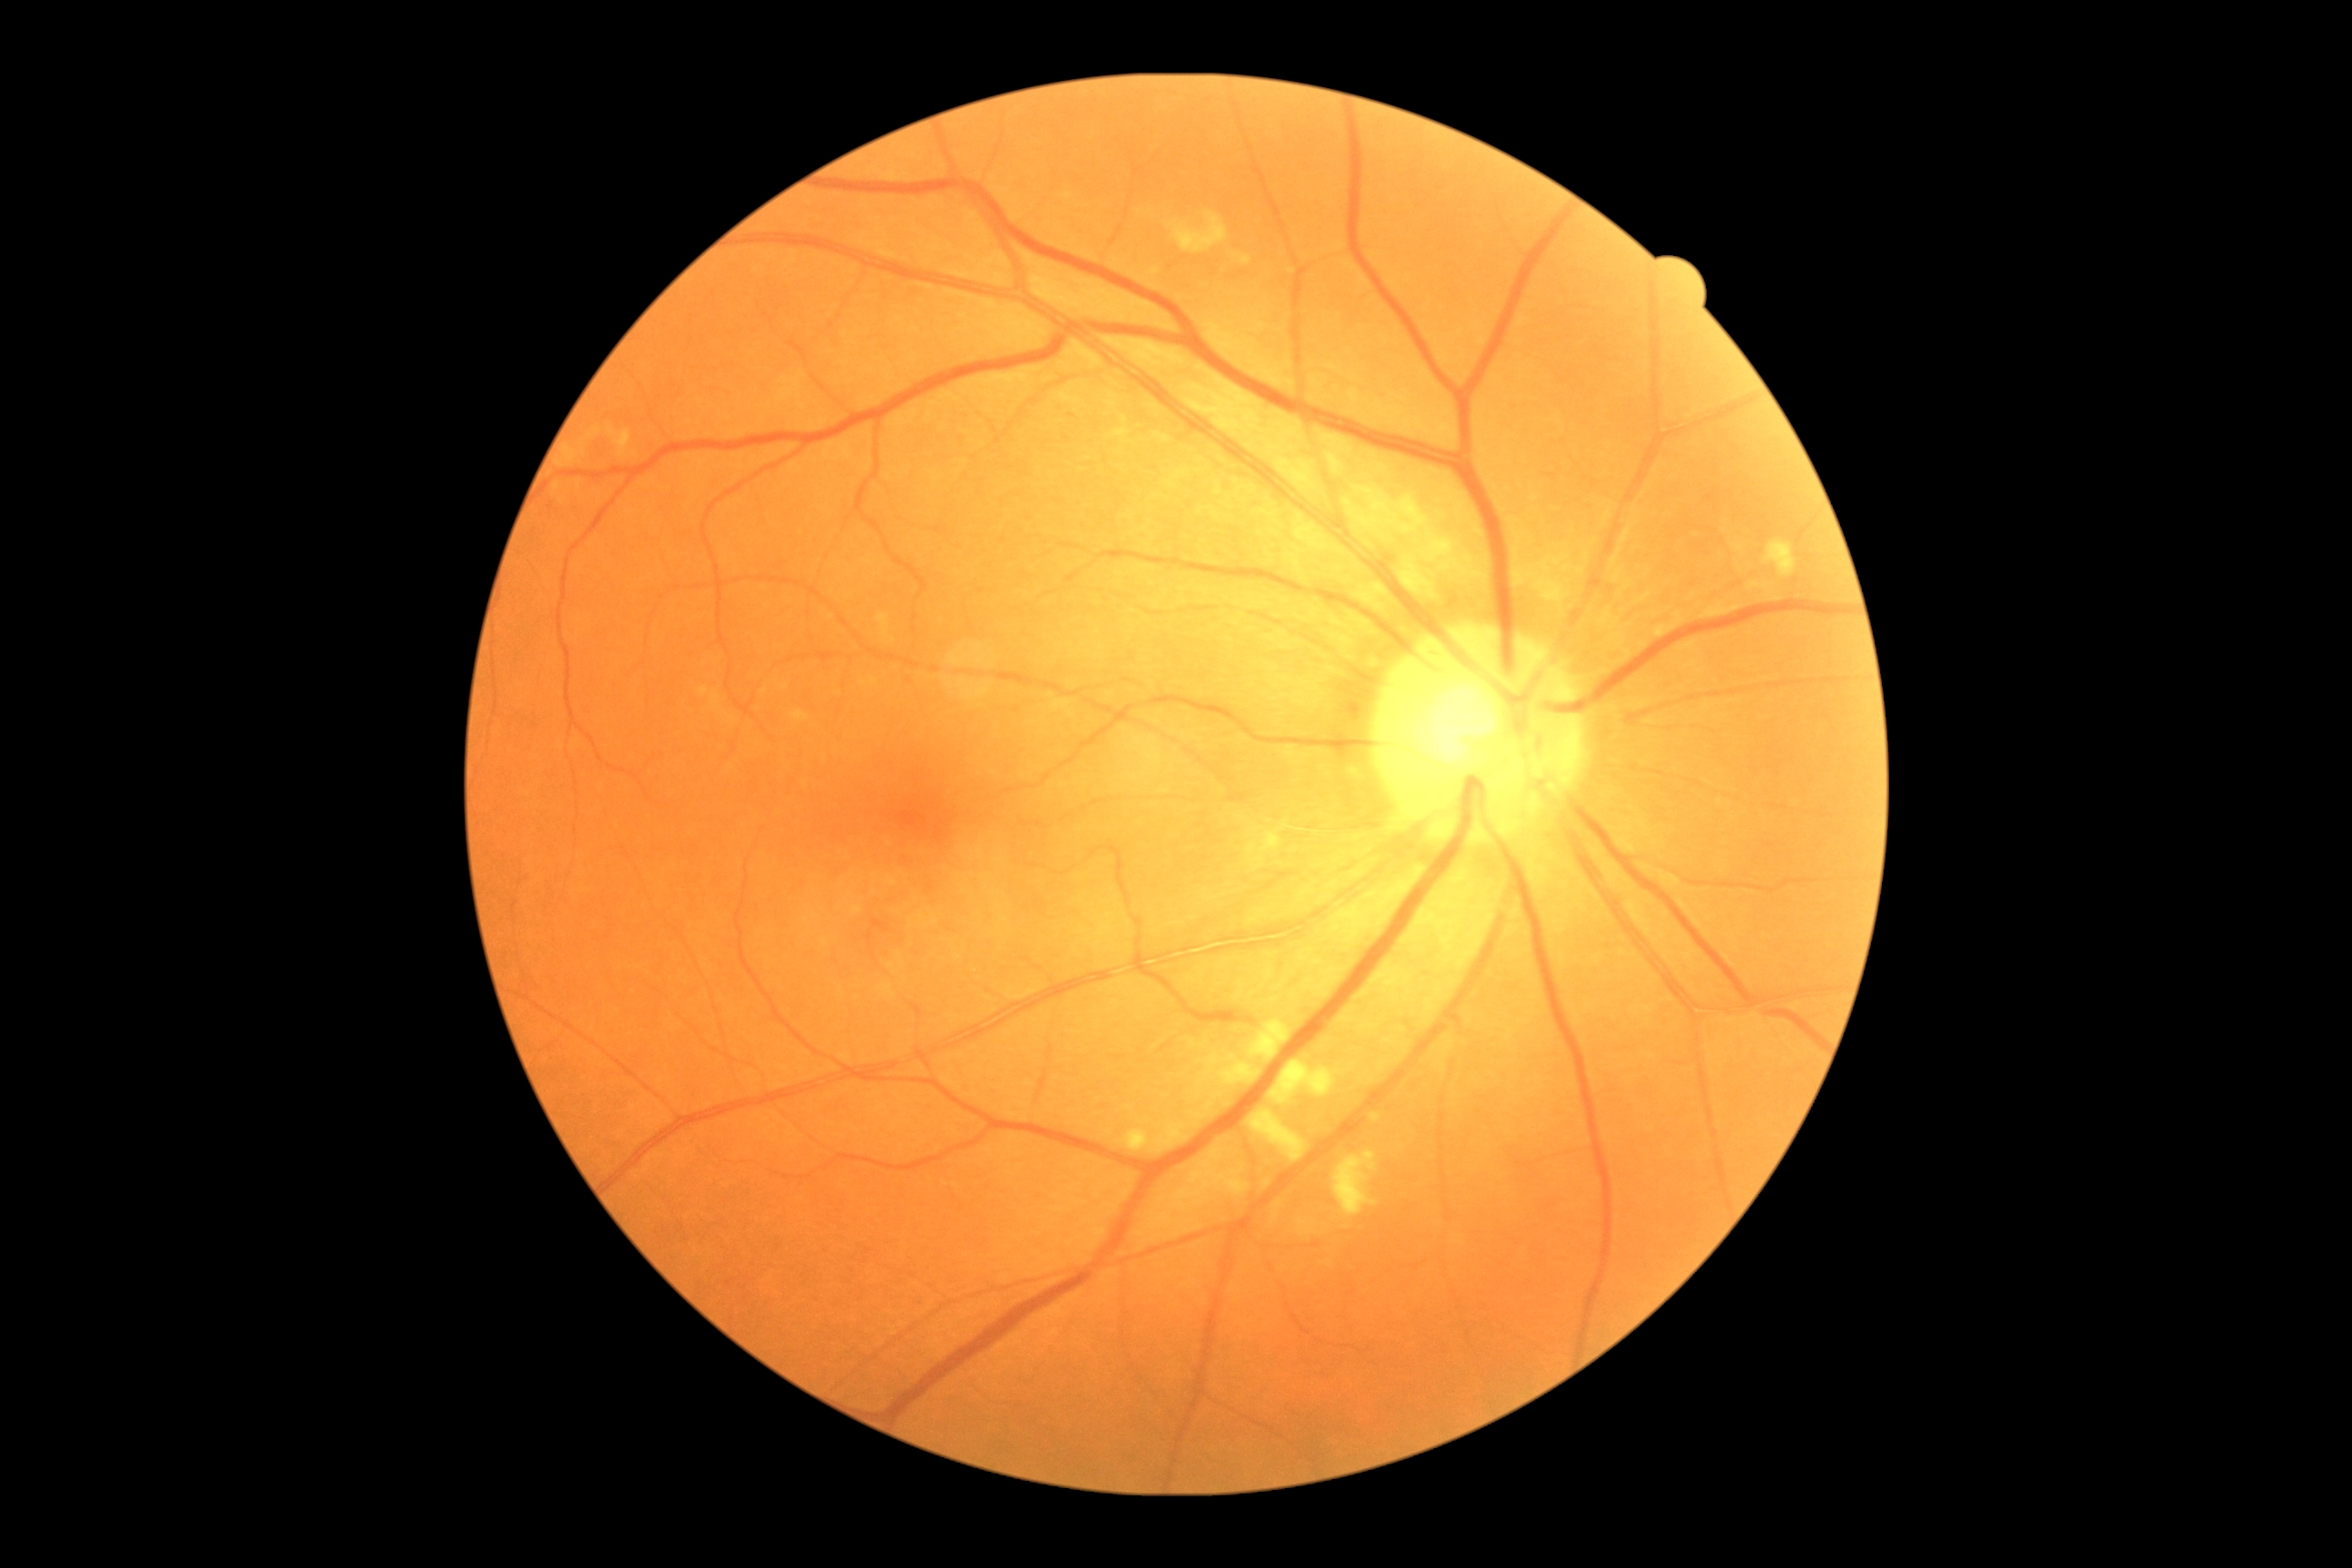

Diabetic retinopathy: 2/4.